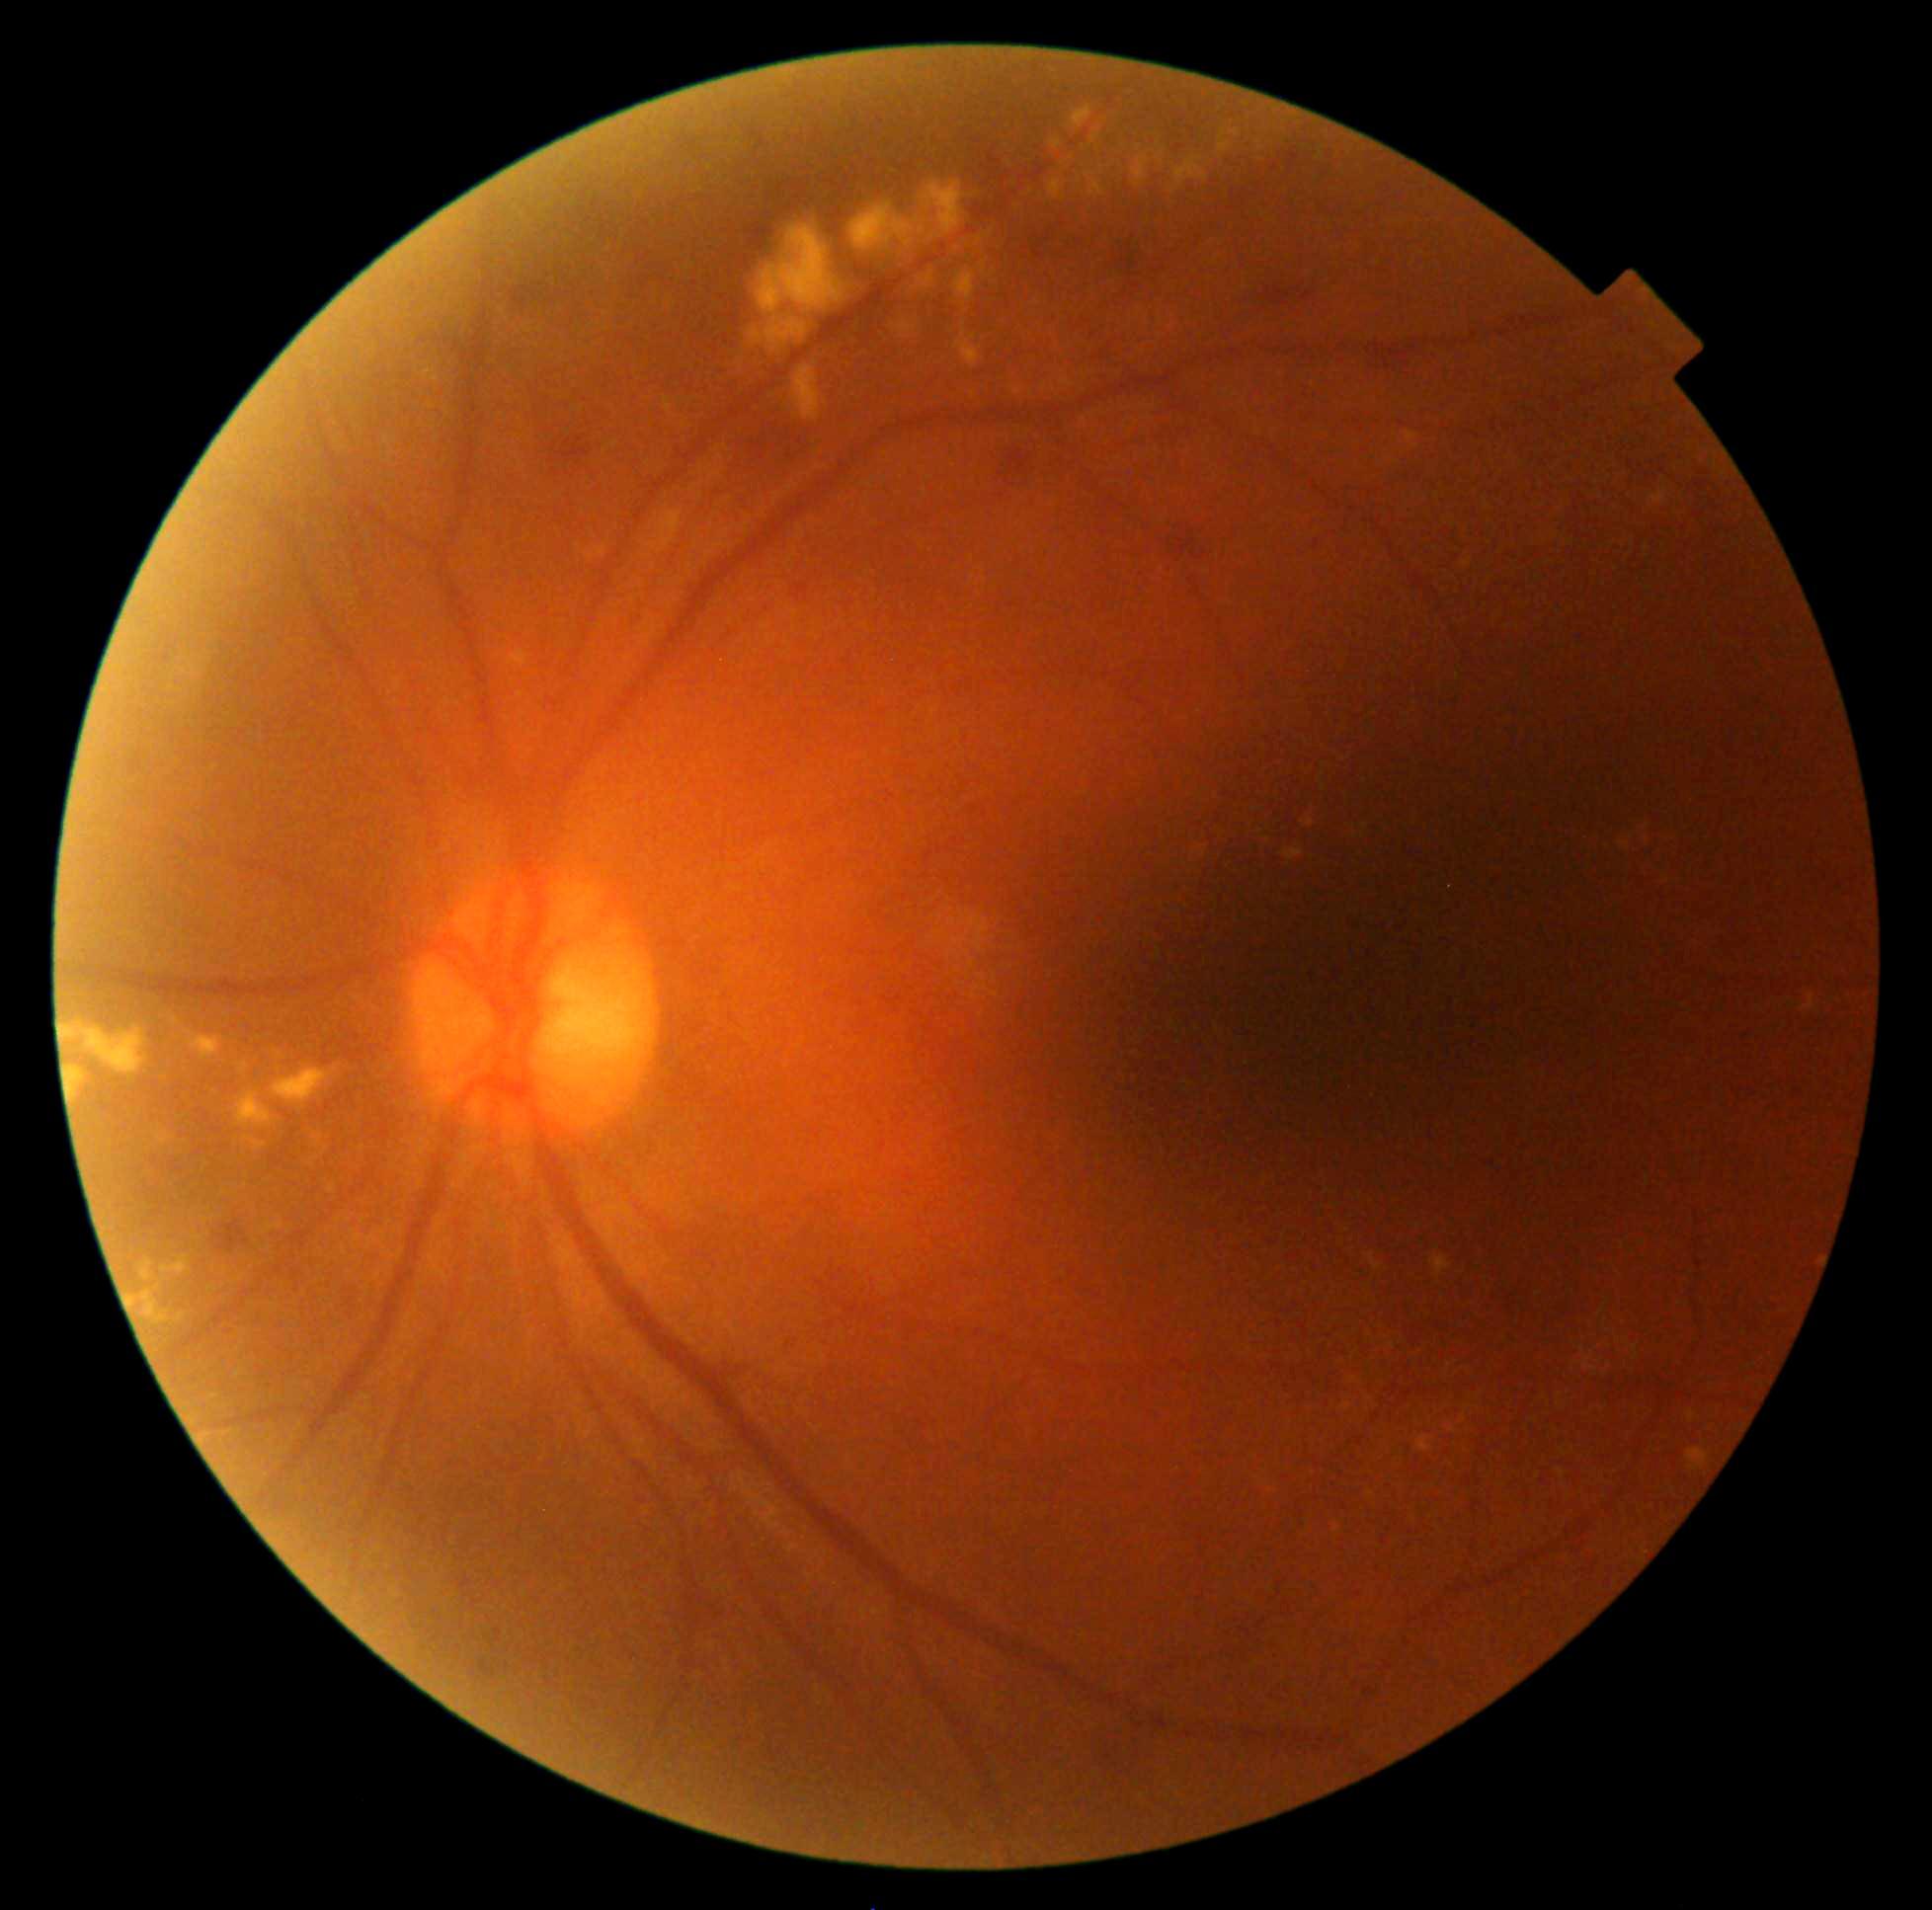

partial: true
dr_grade: 2
dr_grade_name: moderate NPDR
lesions:
  ex:
    - region(954, 329, 982, 368)
    - region(1232, 129, 1241, 136)
    - region(1049, 179, 1065, 200)
    - region(792, 366, 821, 422)
    - region(242, 1063, 249, 1074)
    - region(424, 370, 437, 377)
    - region(1405, 431, 1419, 443)
    - region(954, 272, 976, 300)
    - region(62, 1025, 149, 1075)
    - region(1283, 848, 1305, 861)
    - region(156, 1131, 172, 1145)
    - region(1085, 172, 1104, 198)
    - region(1062, 379, 1075, 388)
  ex_small:
    - <point>1080, 180</point>
    - <point>108, 1229</point>
    - <point>1648, 827</point>
    - <point>980, 241</point>
    - <point>332, 1189</point>
    - <point>1449, 1365</point>
  he:
    - region(1261, 288, 1290, 306)
    - region(1301, 291, 1314, 302)
    - region(1177, 539, 1195, 556)
    - region(479, 1661, 497, 1679)
    - region(746, 223, 774, 253)
    - region(987, 443, 1037, 512)
    - region(563, 439, 572, 448)
    - region(1115, 233, 1148, 295)
  he_small:
    - <point>549, 431</point>
    - <point>554, 446</point>